45° field of view:
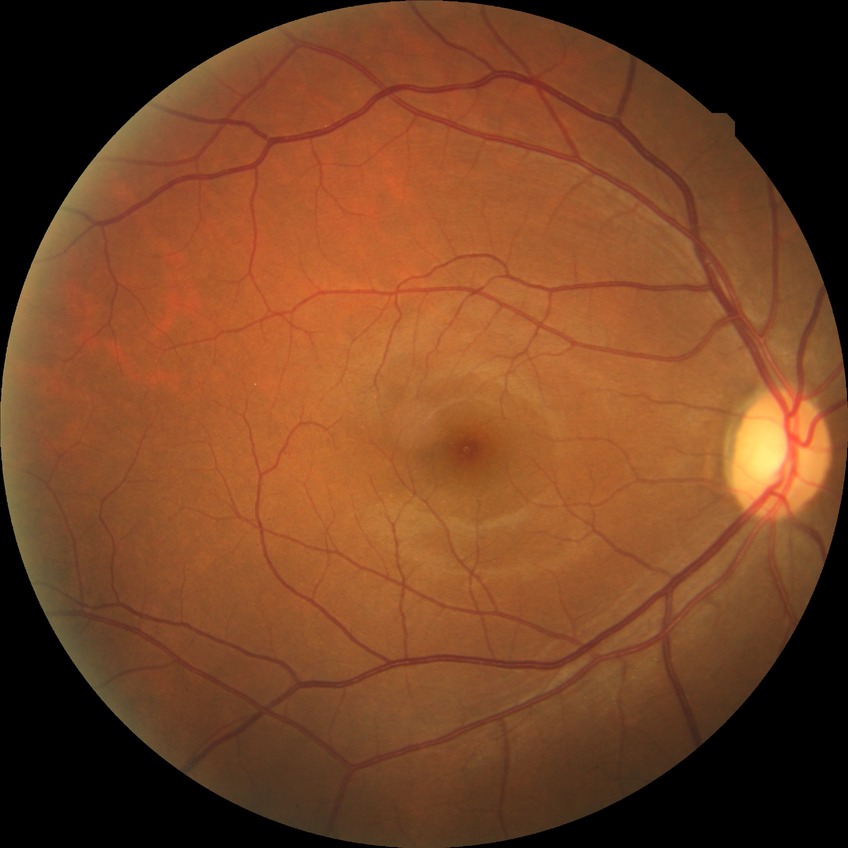

davis_grade: NDR (no diabetic retinopathy)